Camera: NIDEK AFC-230 — 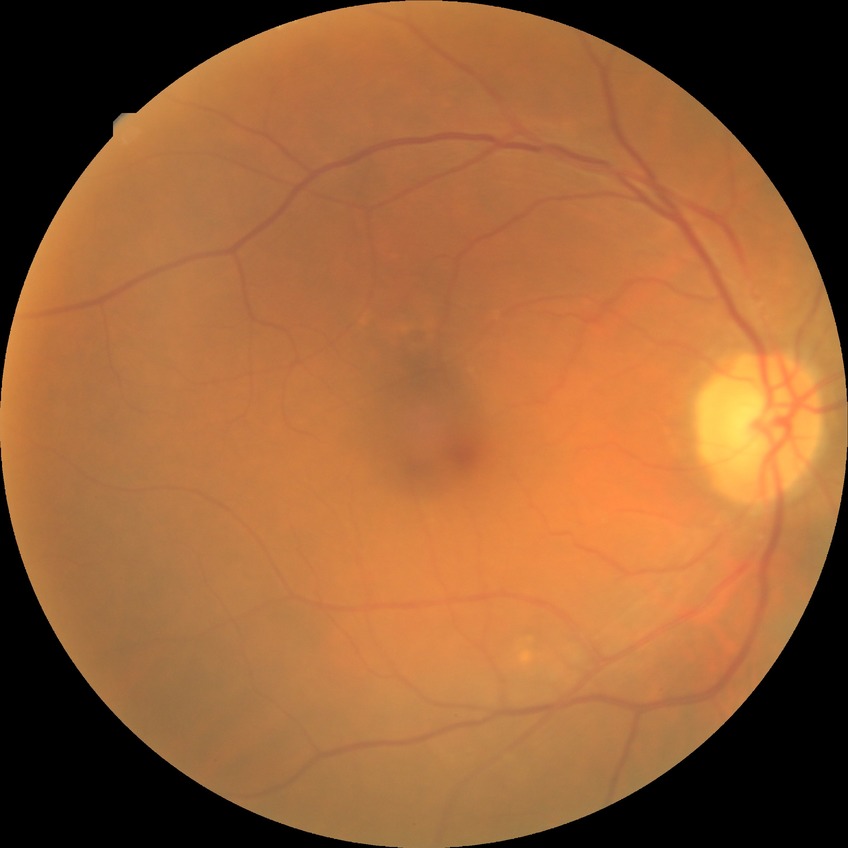
Modified Davis classification is no diabetic retinopathy.